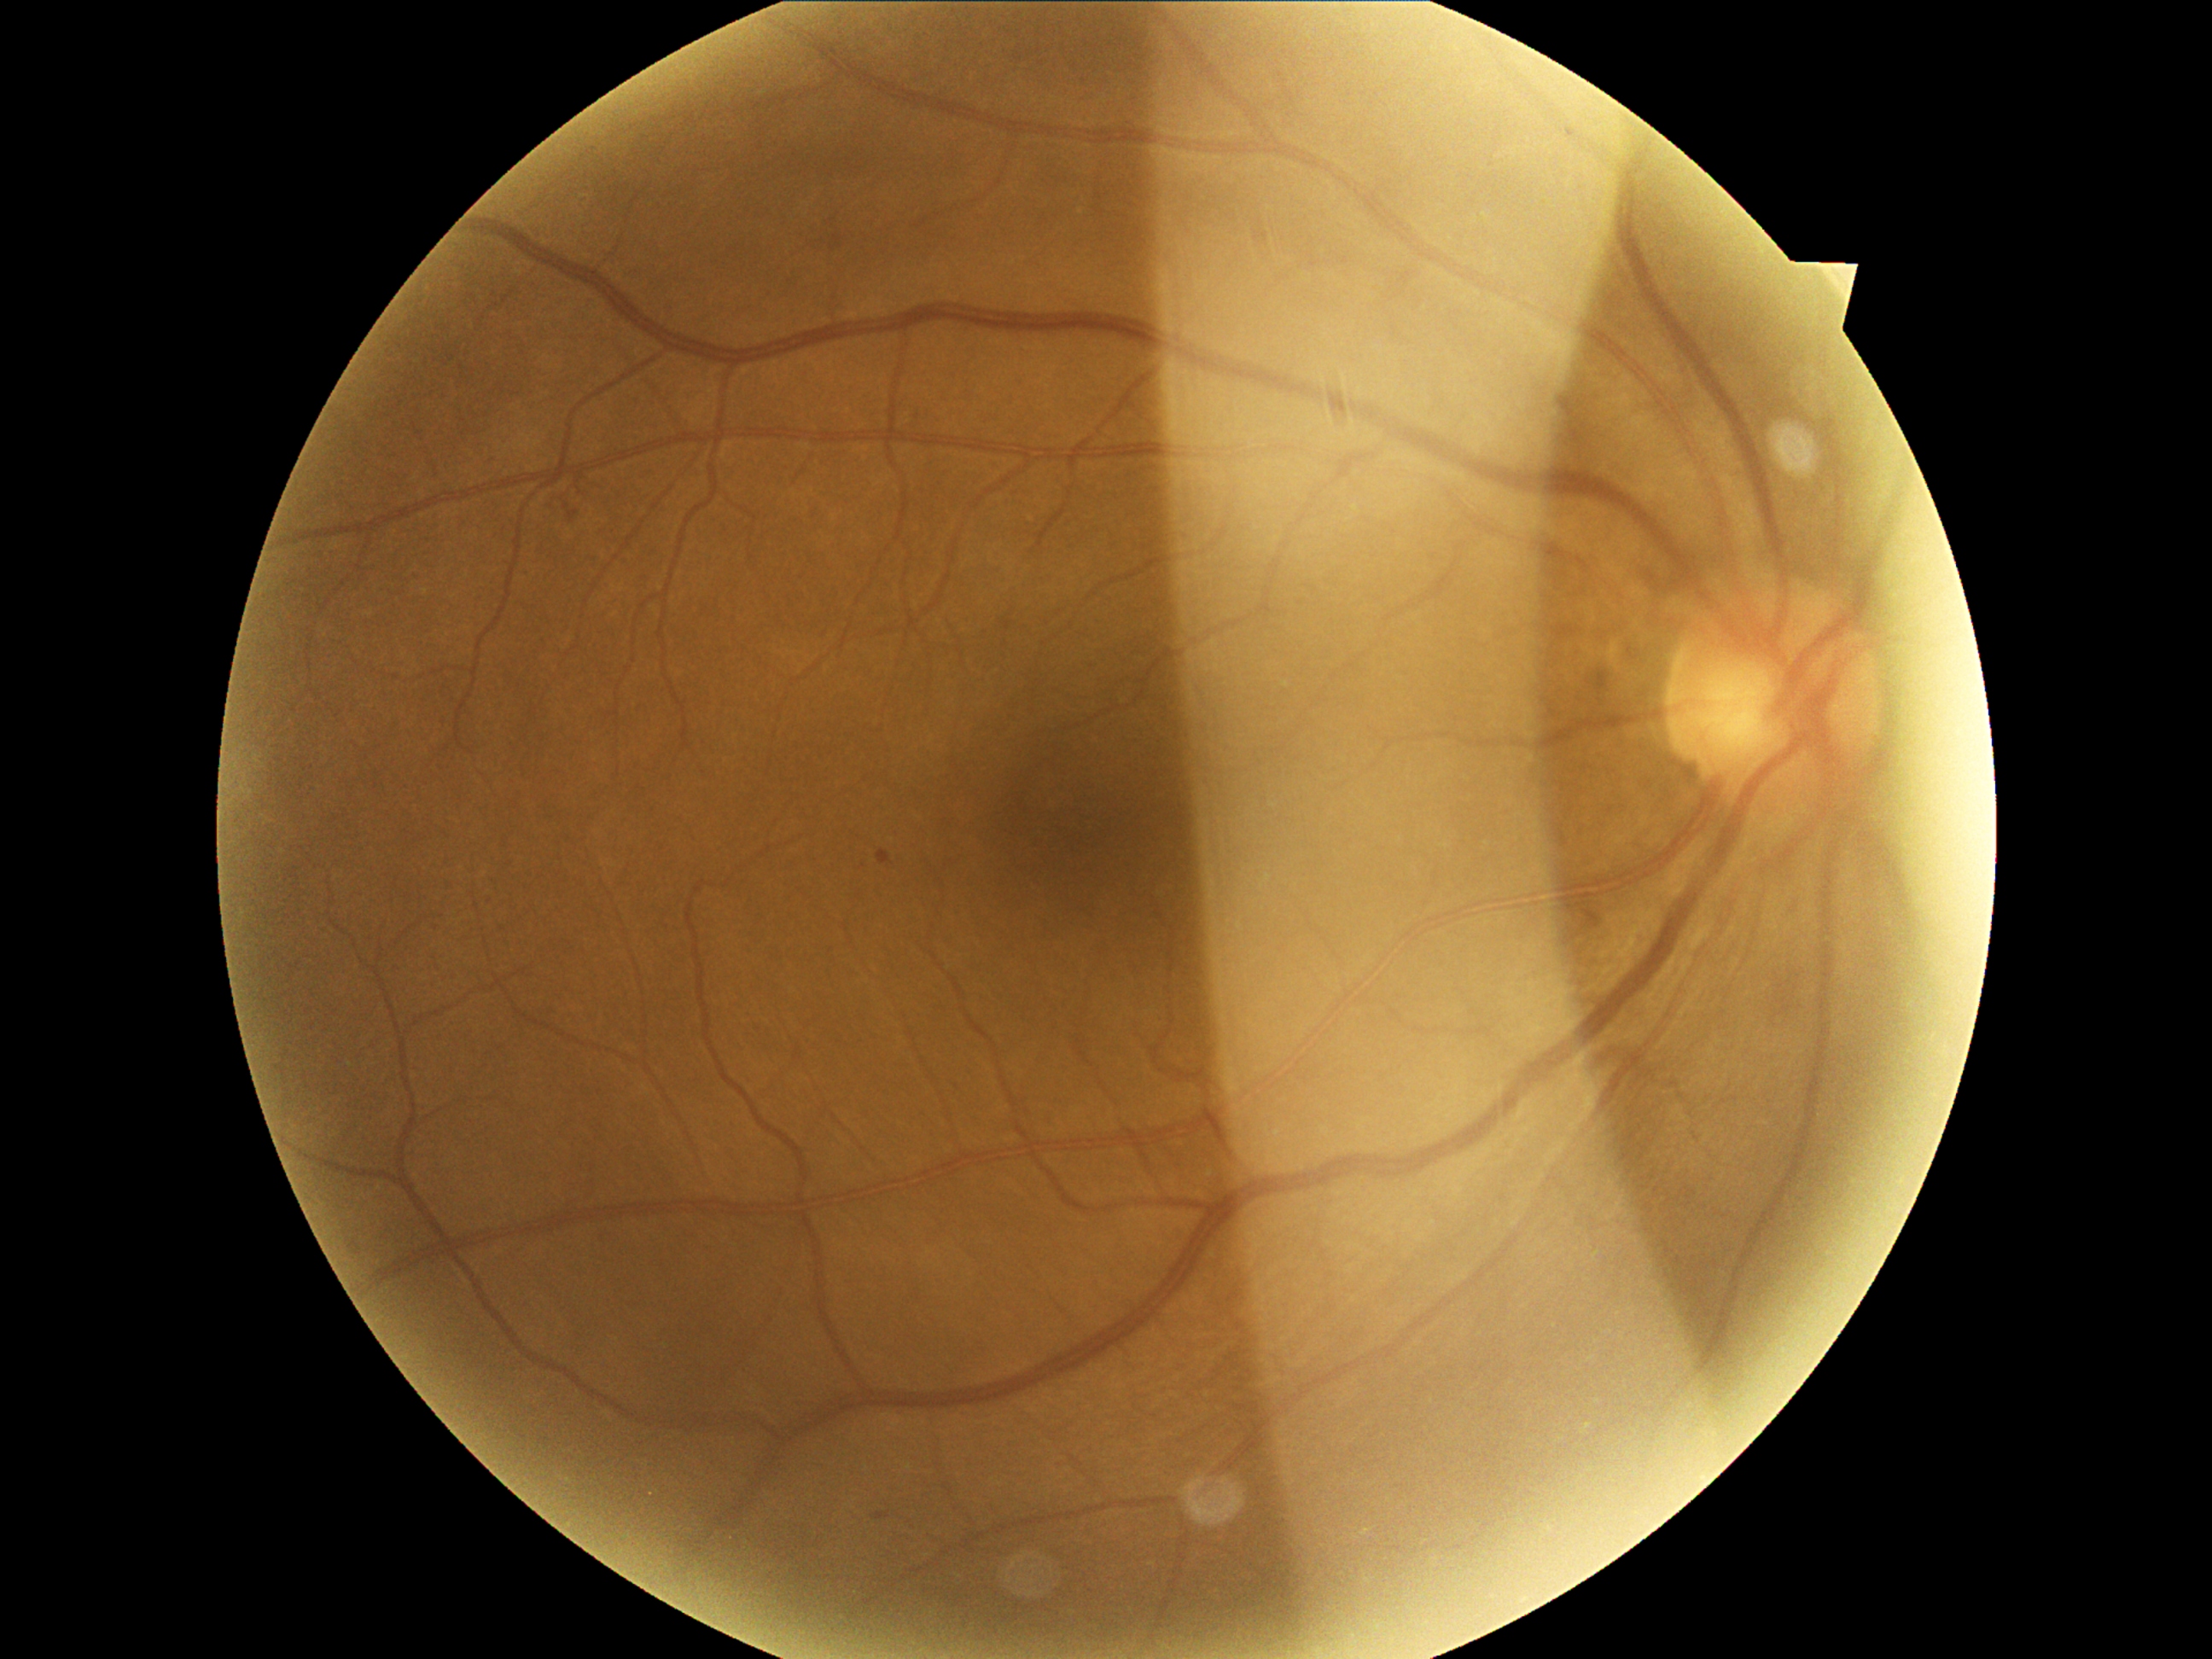

Diabetic retinopathy severity is grade 2 (moderate NPDR).